Color fundus photograph. 2352x1568: 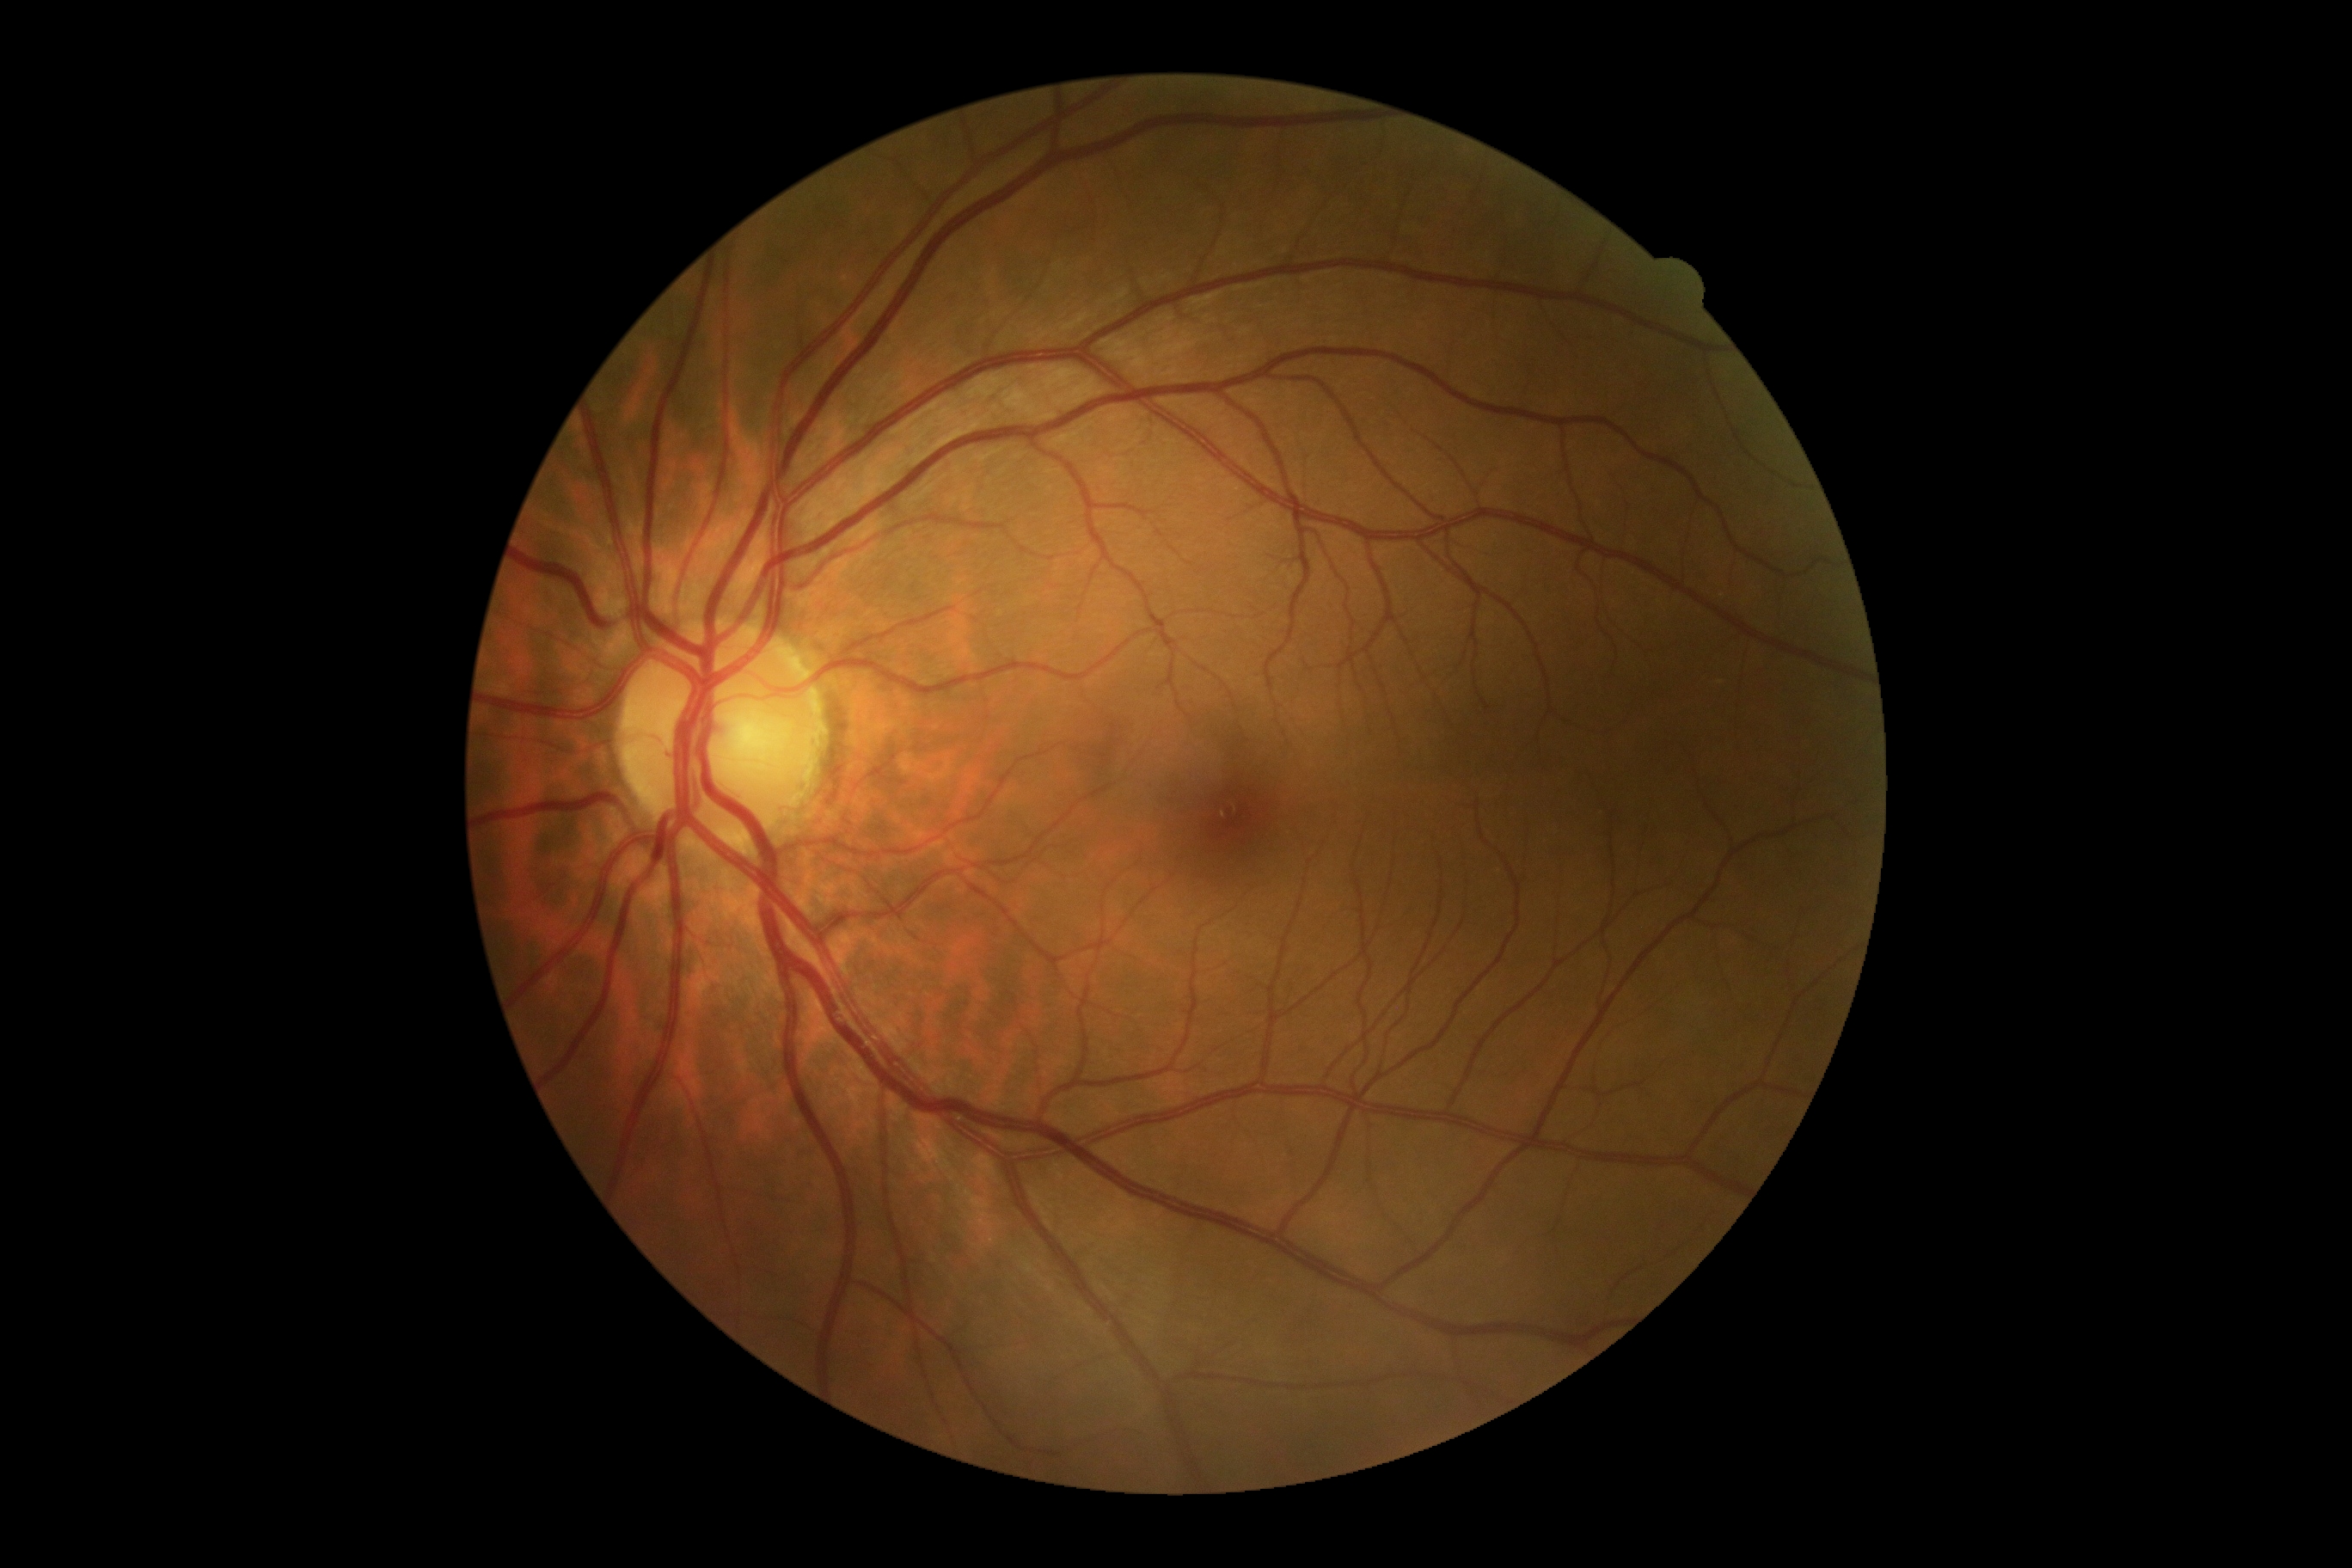 DR stage is grade 0 (no apparent retinopathy).